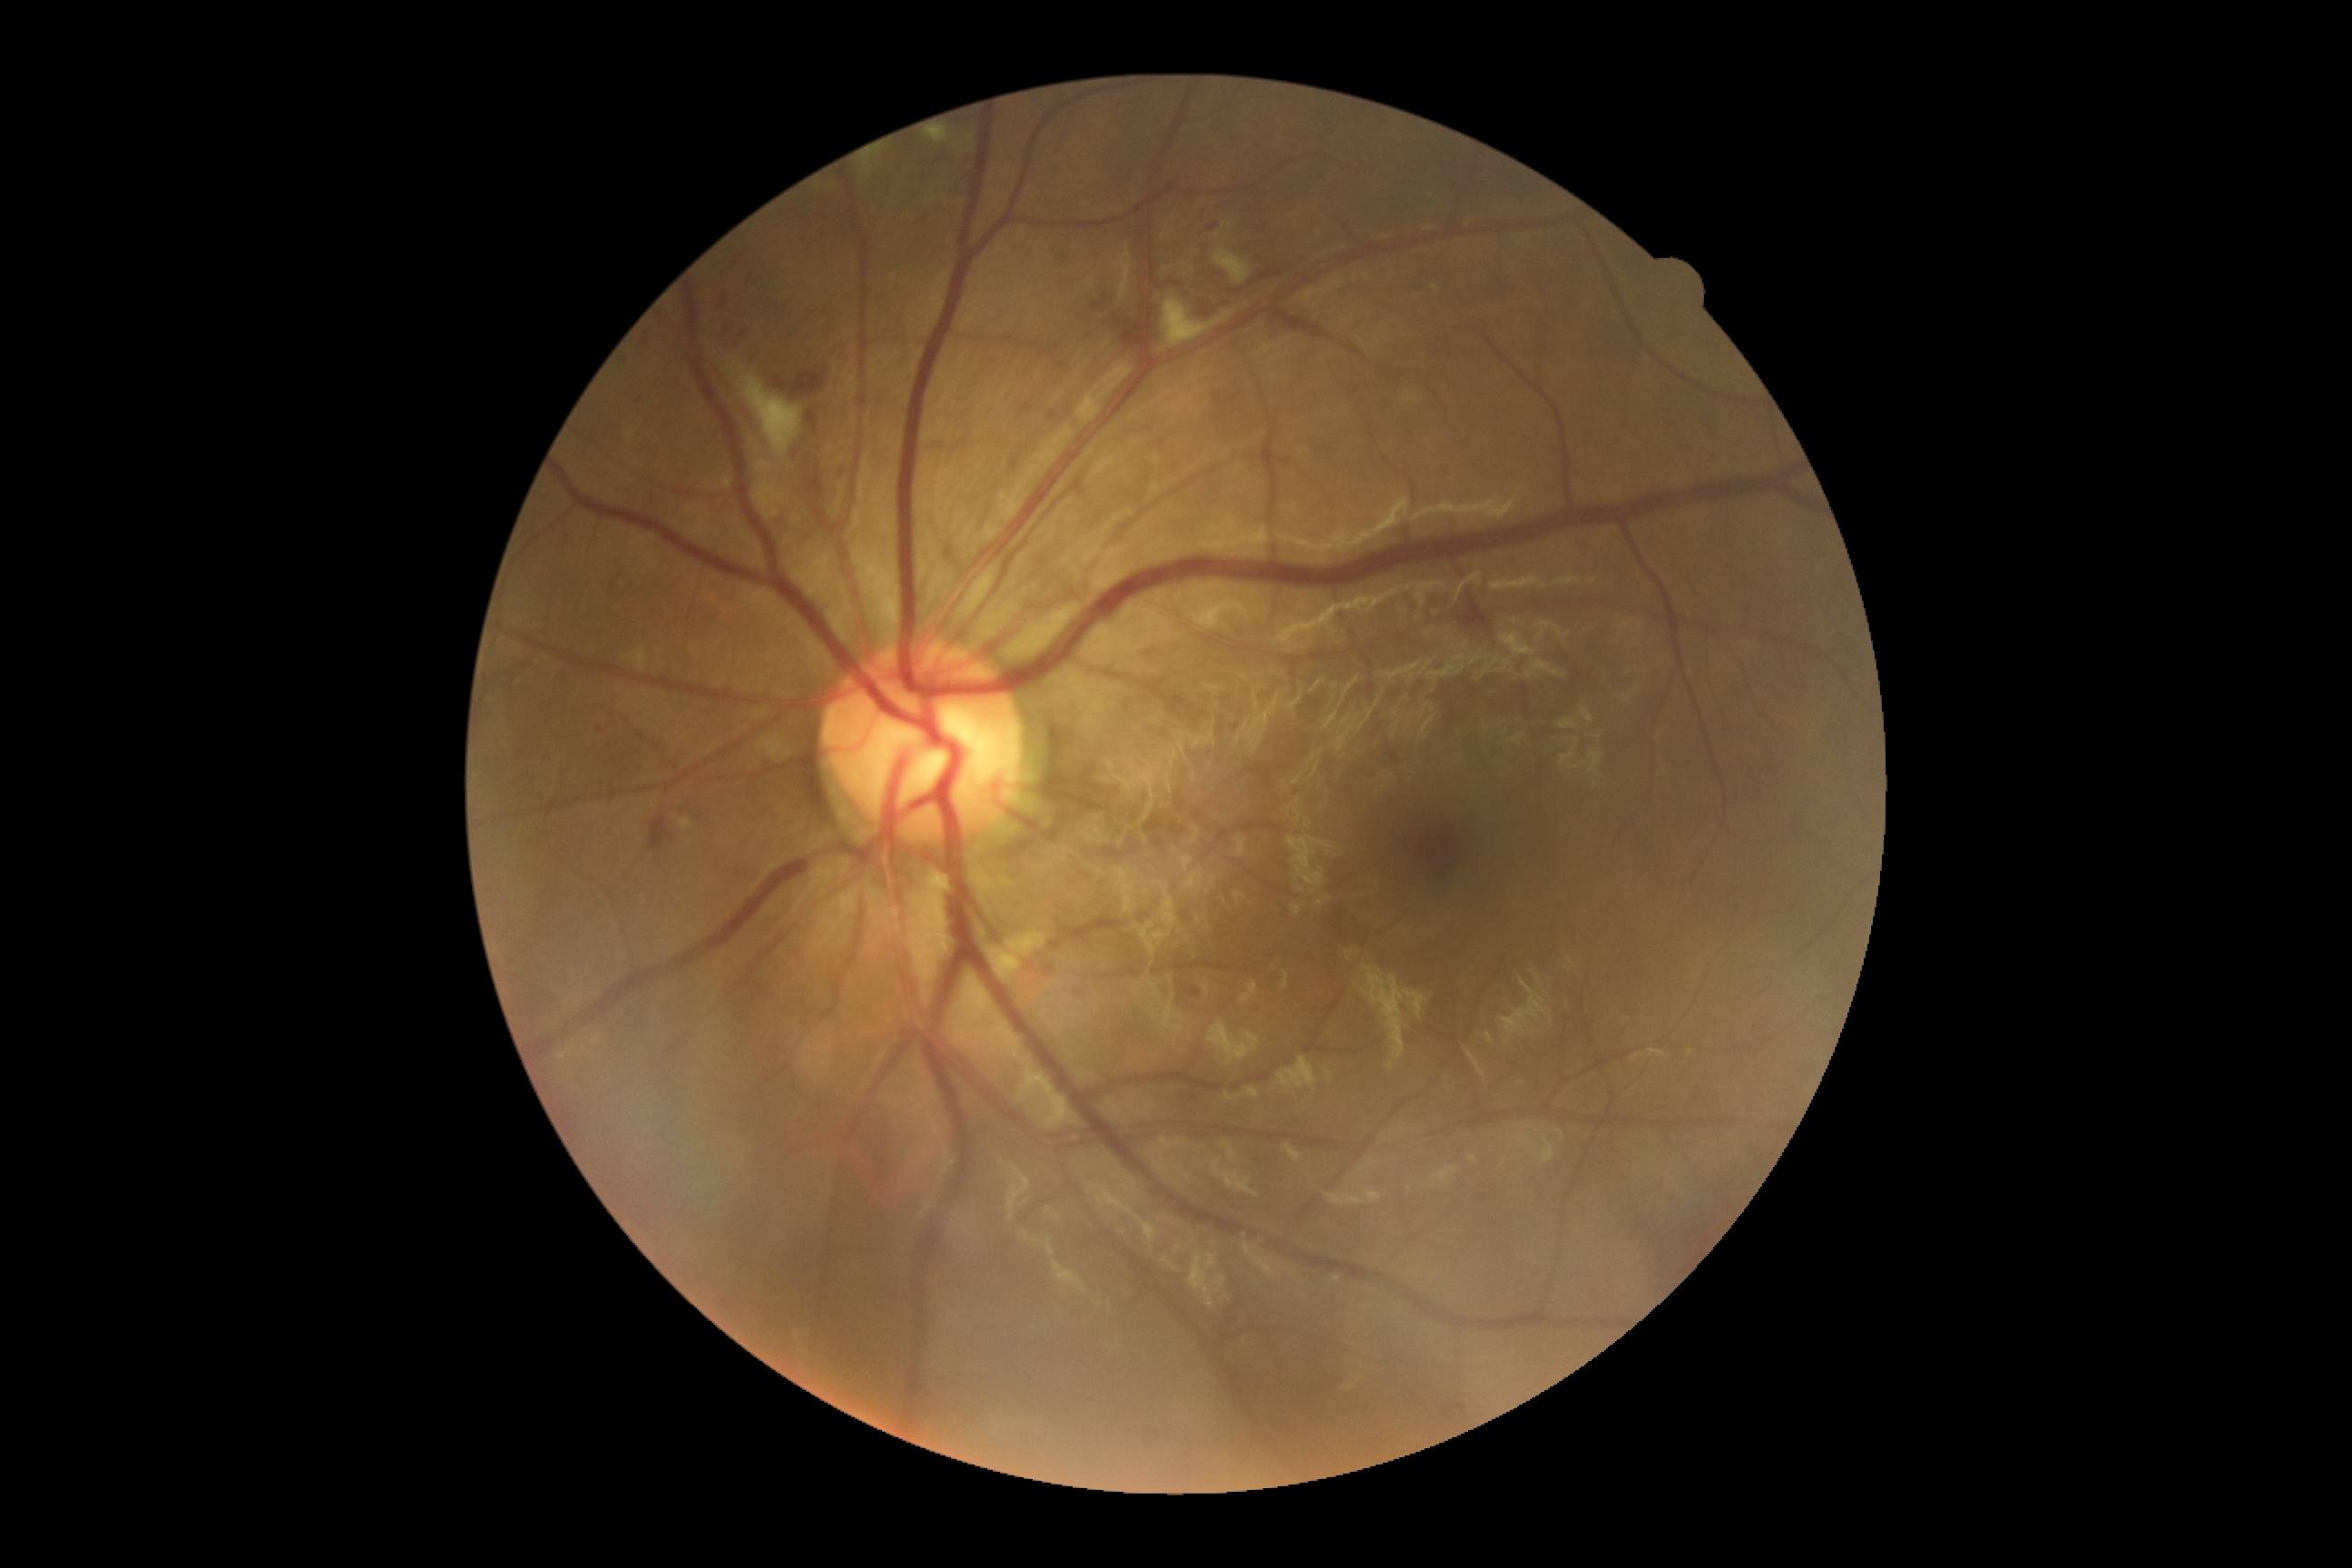

DR is moderate NPDR (grade 2).